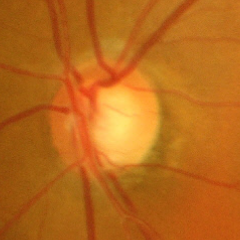
Q: Glaucoma assessment?
A: Severe glaucomatous damage.